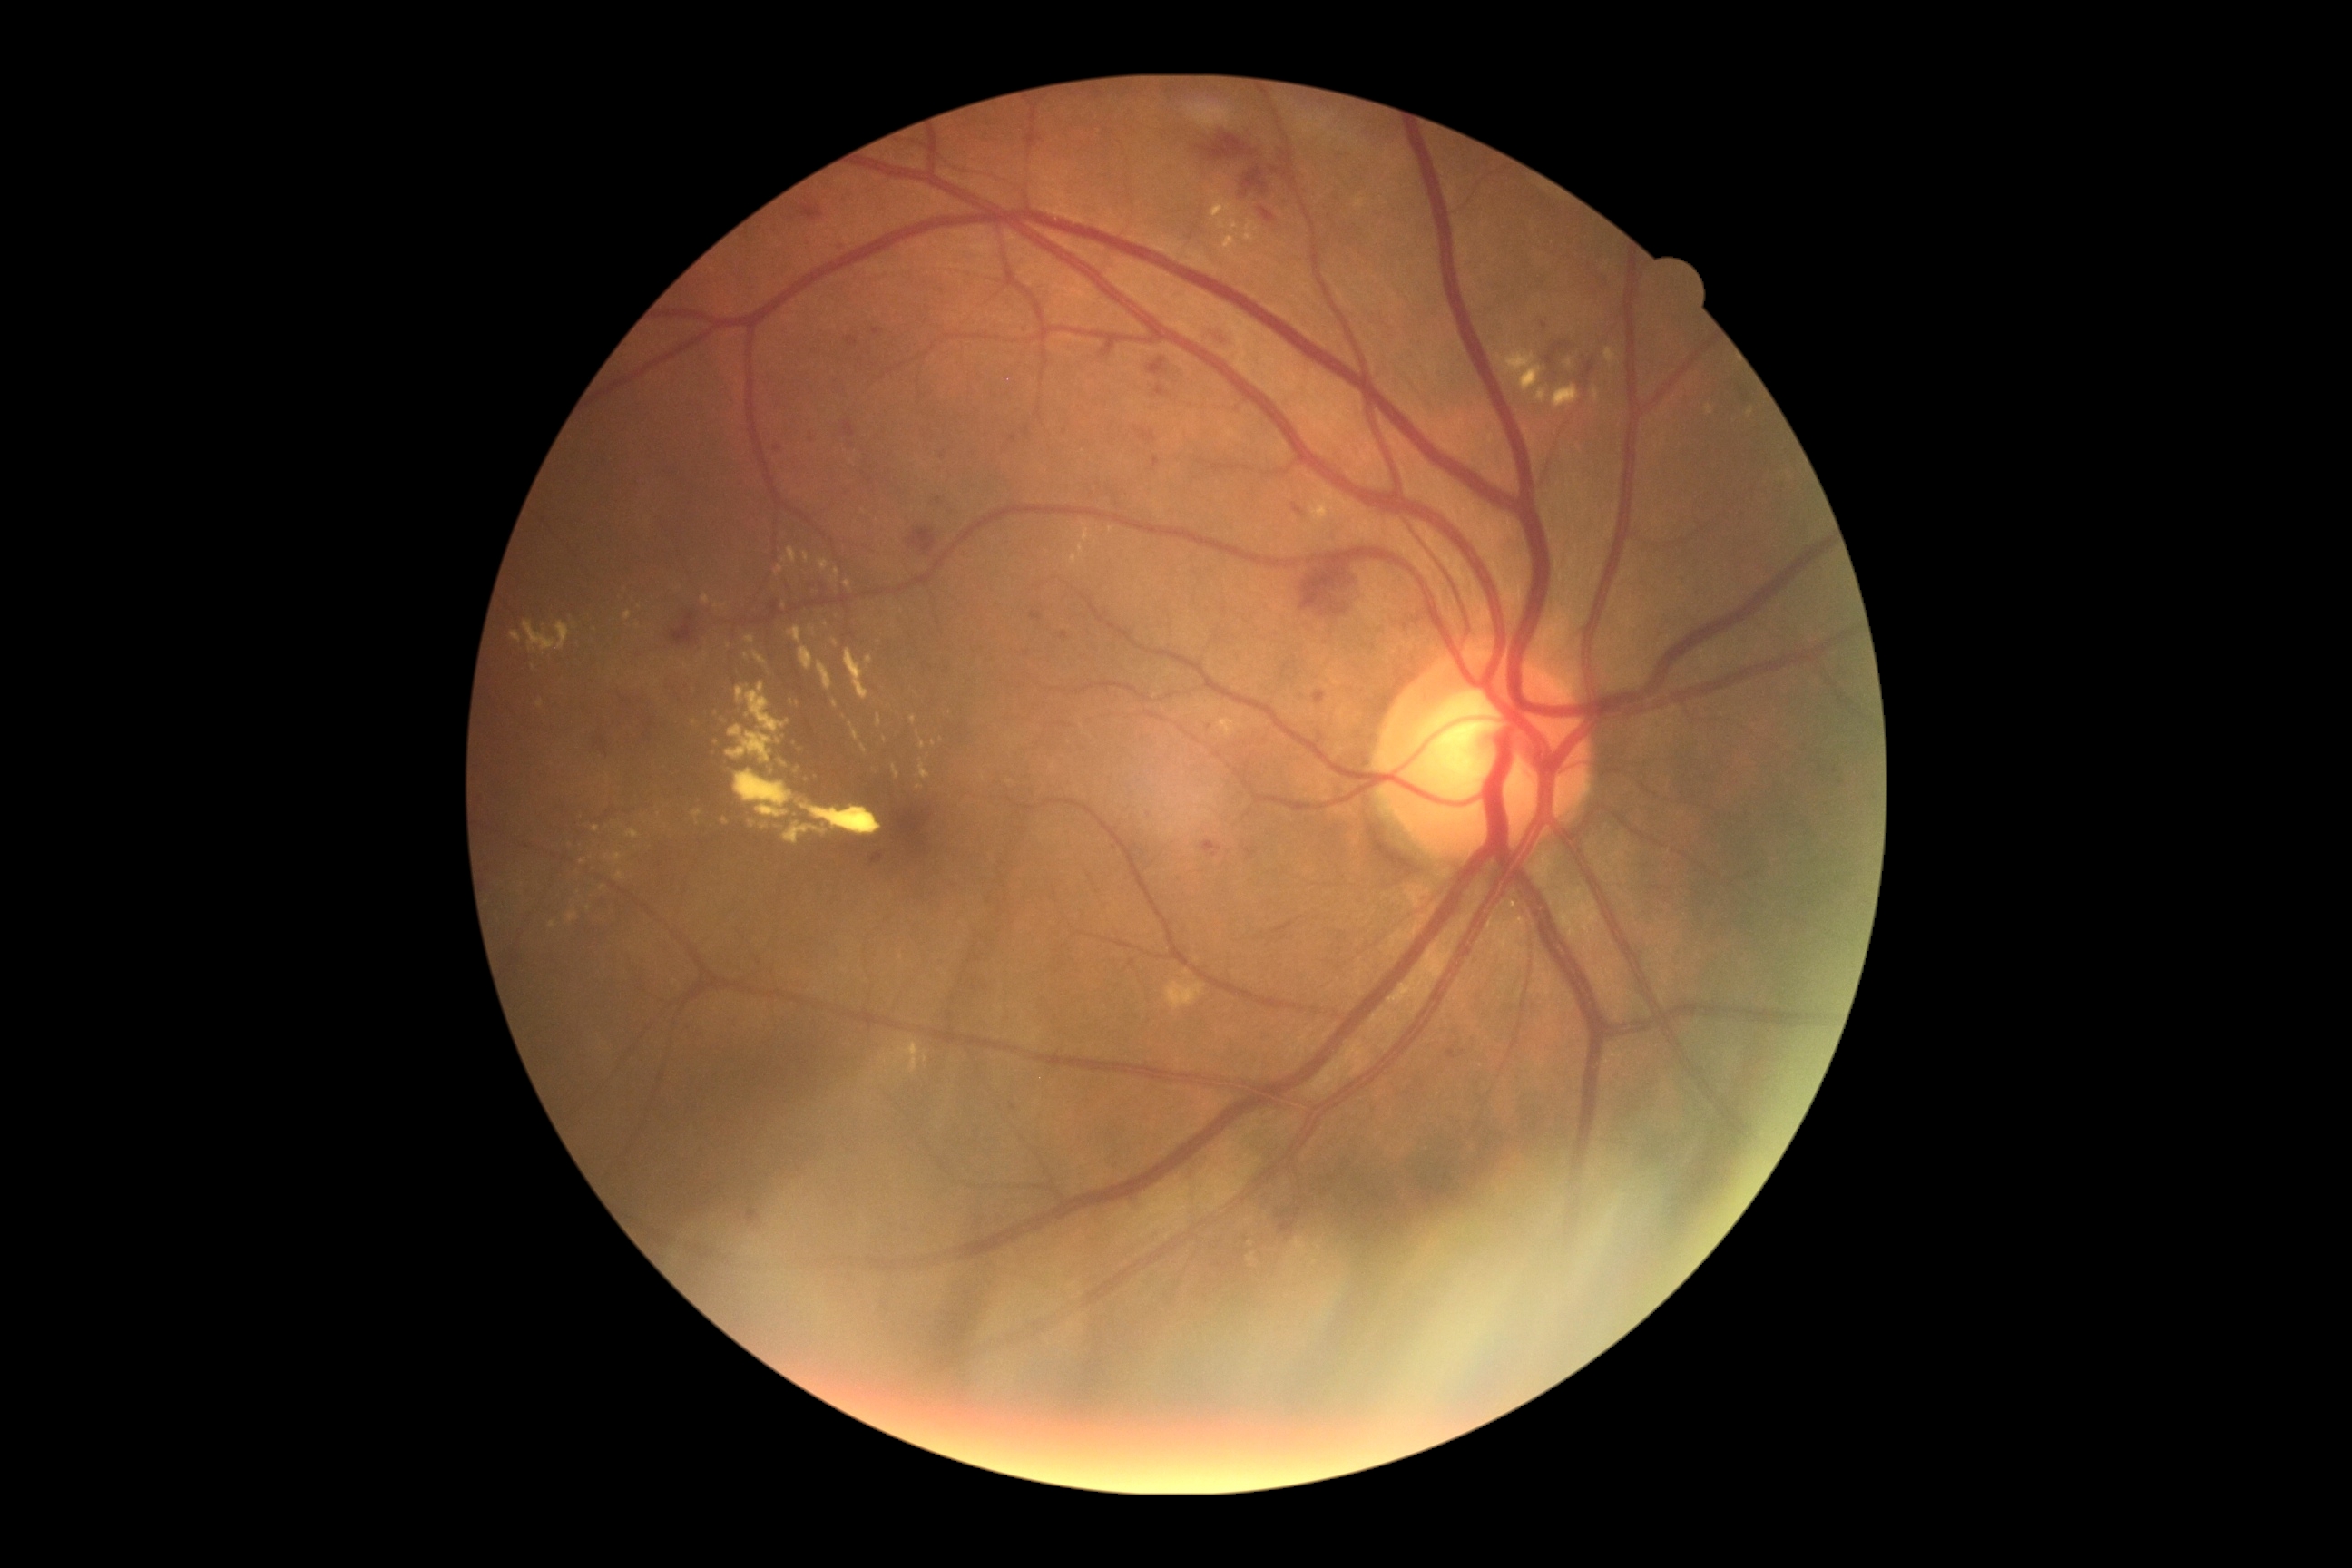

Diabetic retinopathy (DR): grade 2 (moderate NPDR); non-proliferative diabetic retinopathy
Selected lesions:
hard exudates (EXs) (more not shown): 790:763:801:772; 1226:235:1239:250; 917:734:926:750; 623:611:632:620; 1505:353:1534:371; 832:569:841:582; 1707:406:1714:415; 910:1041:916:1054; 721:818:729:825; 1231:222:1235:230; 1749:409:1754:418; 1605:348:1618:369; 727:725:772:763
Additional small EXs near <point>808, 778</point>; <point>934, 744</point>; <point>785, 607</point>; <point>589, 908</point>